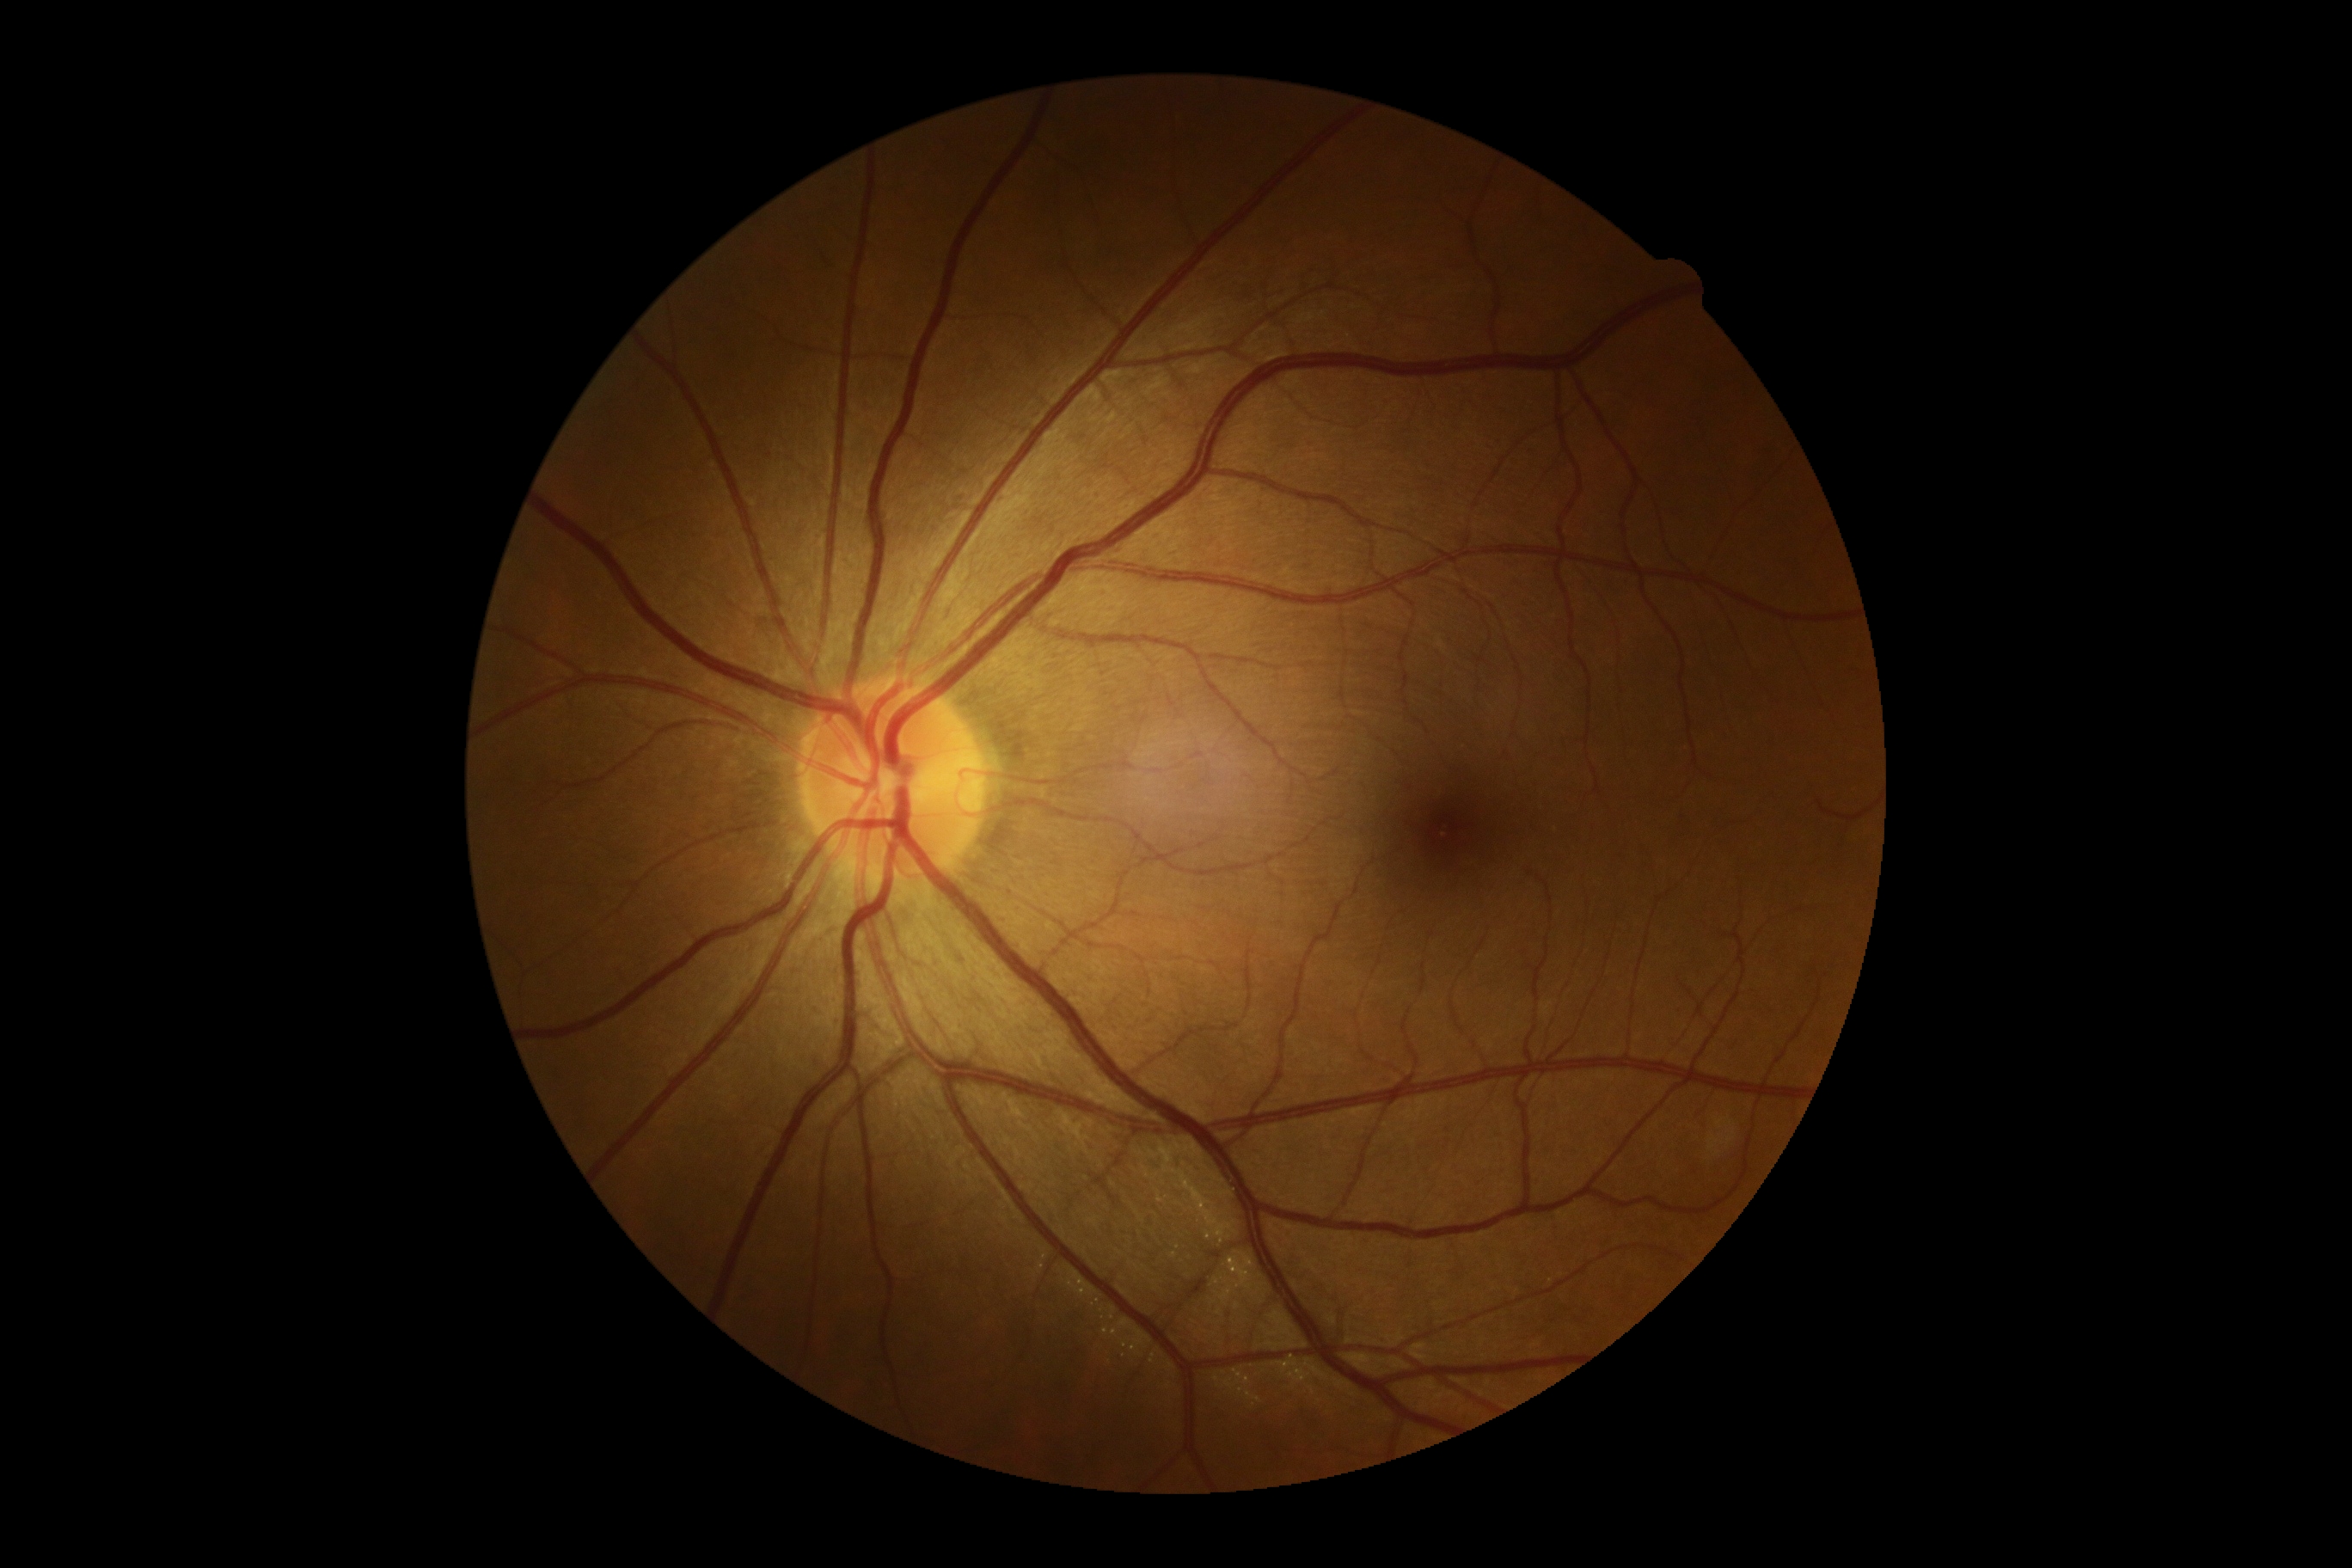
DR grade is 0 (no apparent retinopathy) — no visible signs of diabetic retinopathy.